Fundus photograph cropped around the optic nerve head: 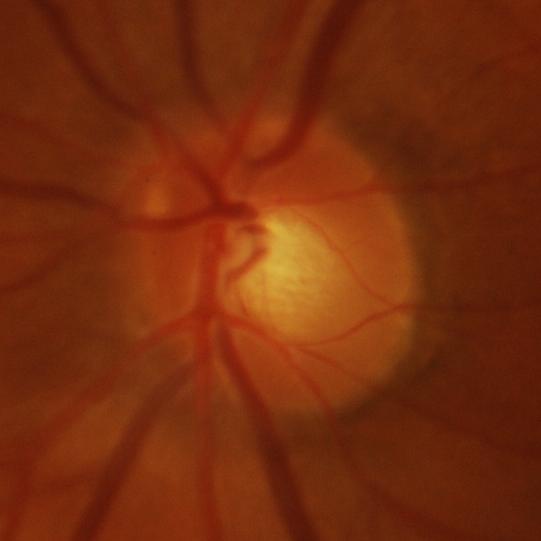 Glaucomatous findings.